RetCam wide-field infant fundus image
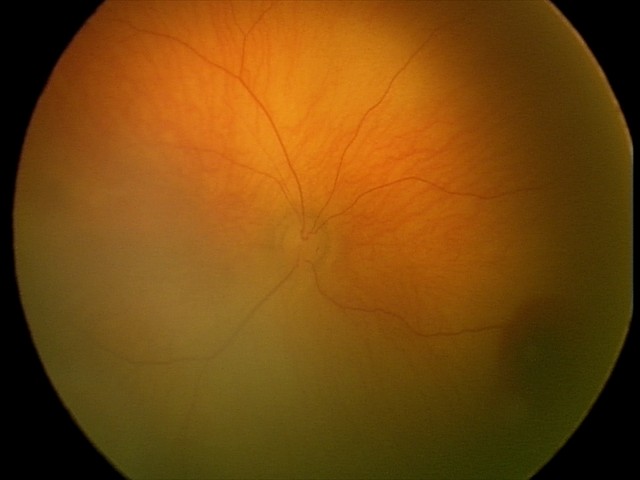 Series diagnosed as retinal hemorrhages.